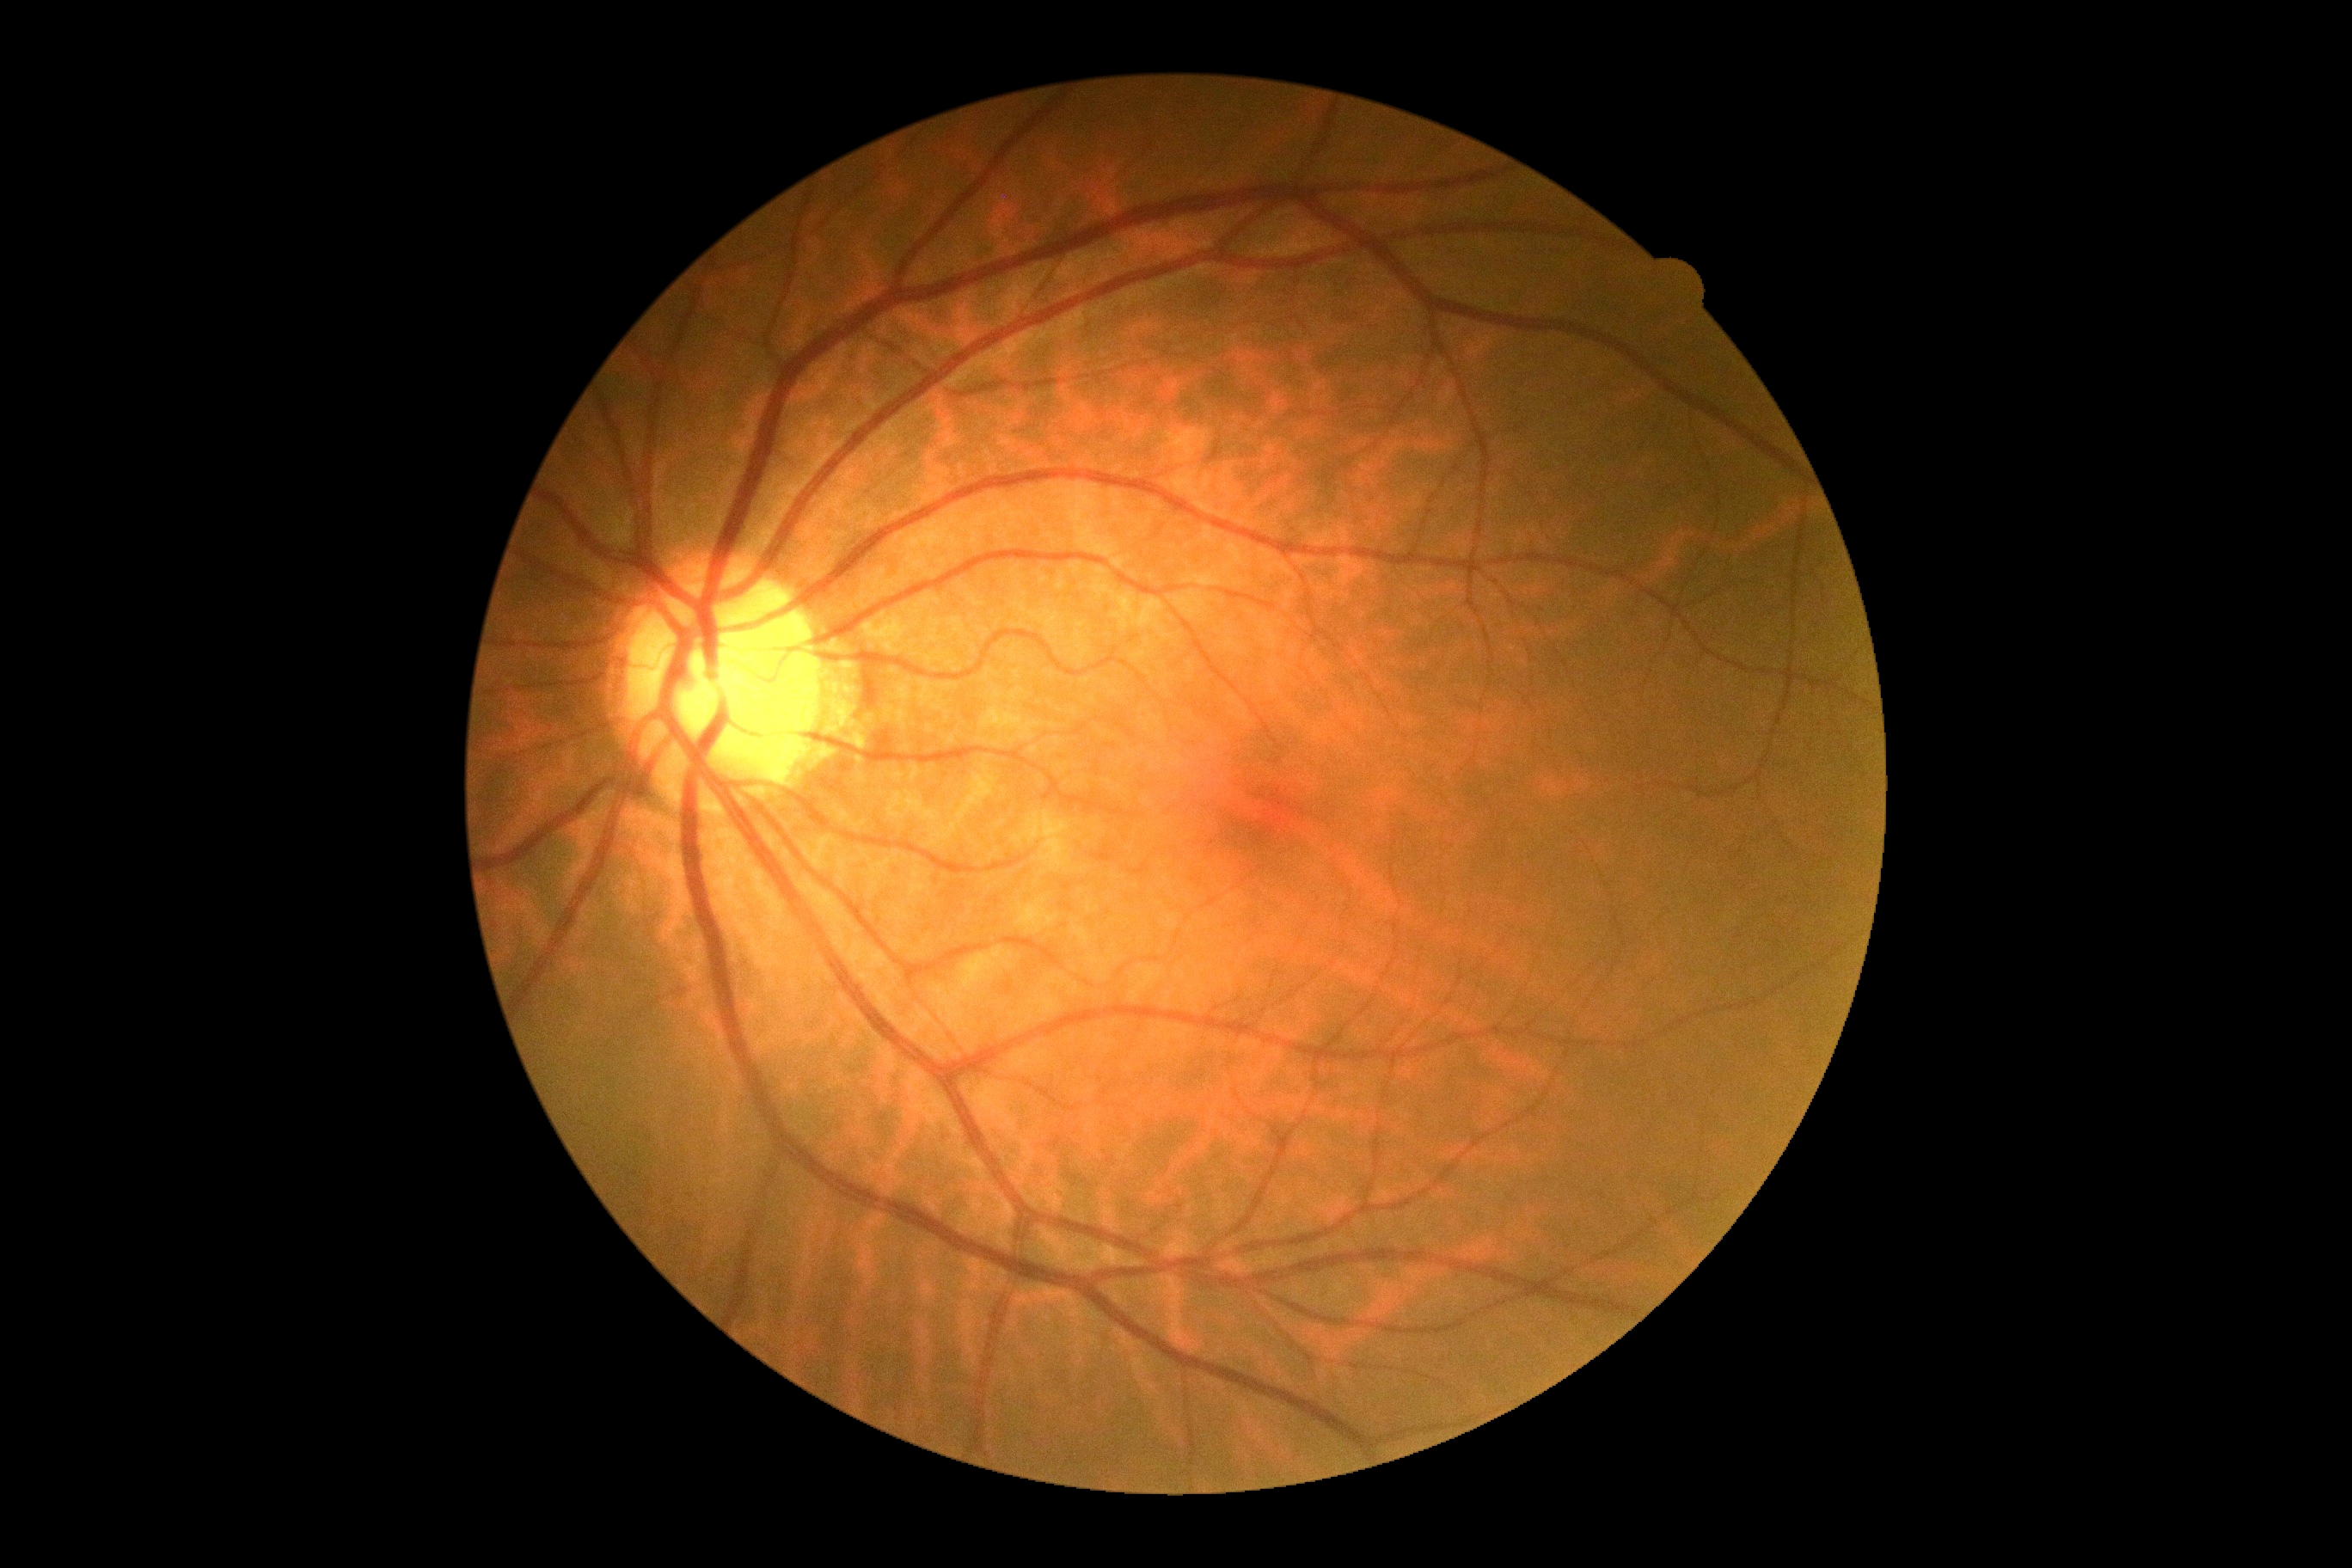
No apparent diabetic retinopathy.
DR grade: 0.